Captured on a Topcon TRC retinal camera. Optic disc region of a color fundus photo
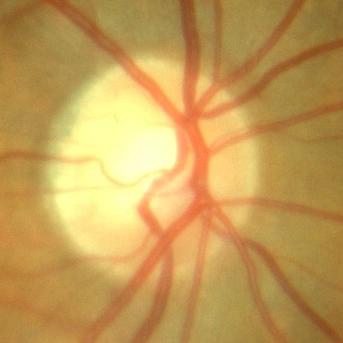
No glaucomatous optic neuropathy.